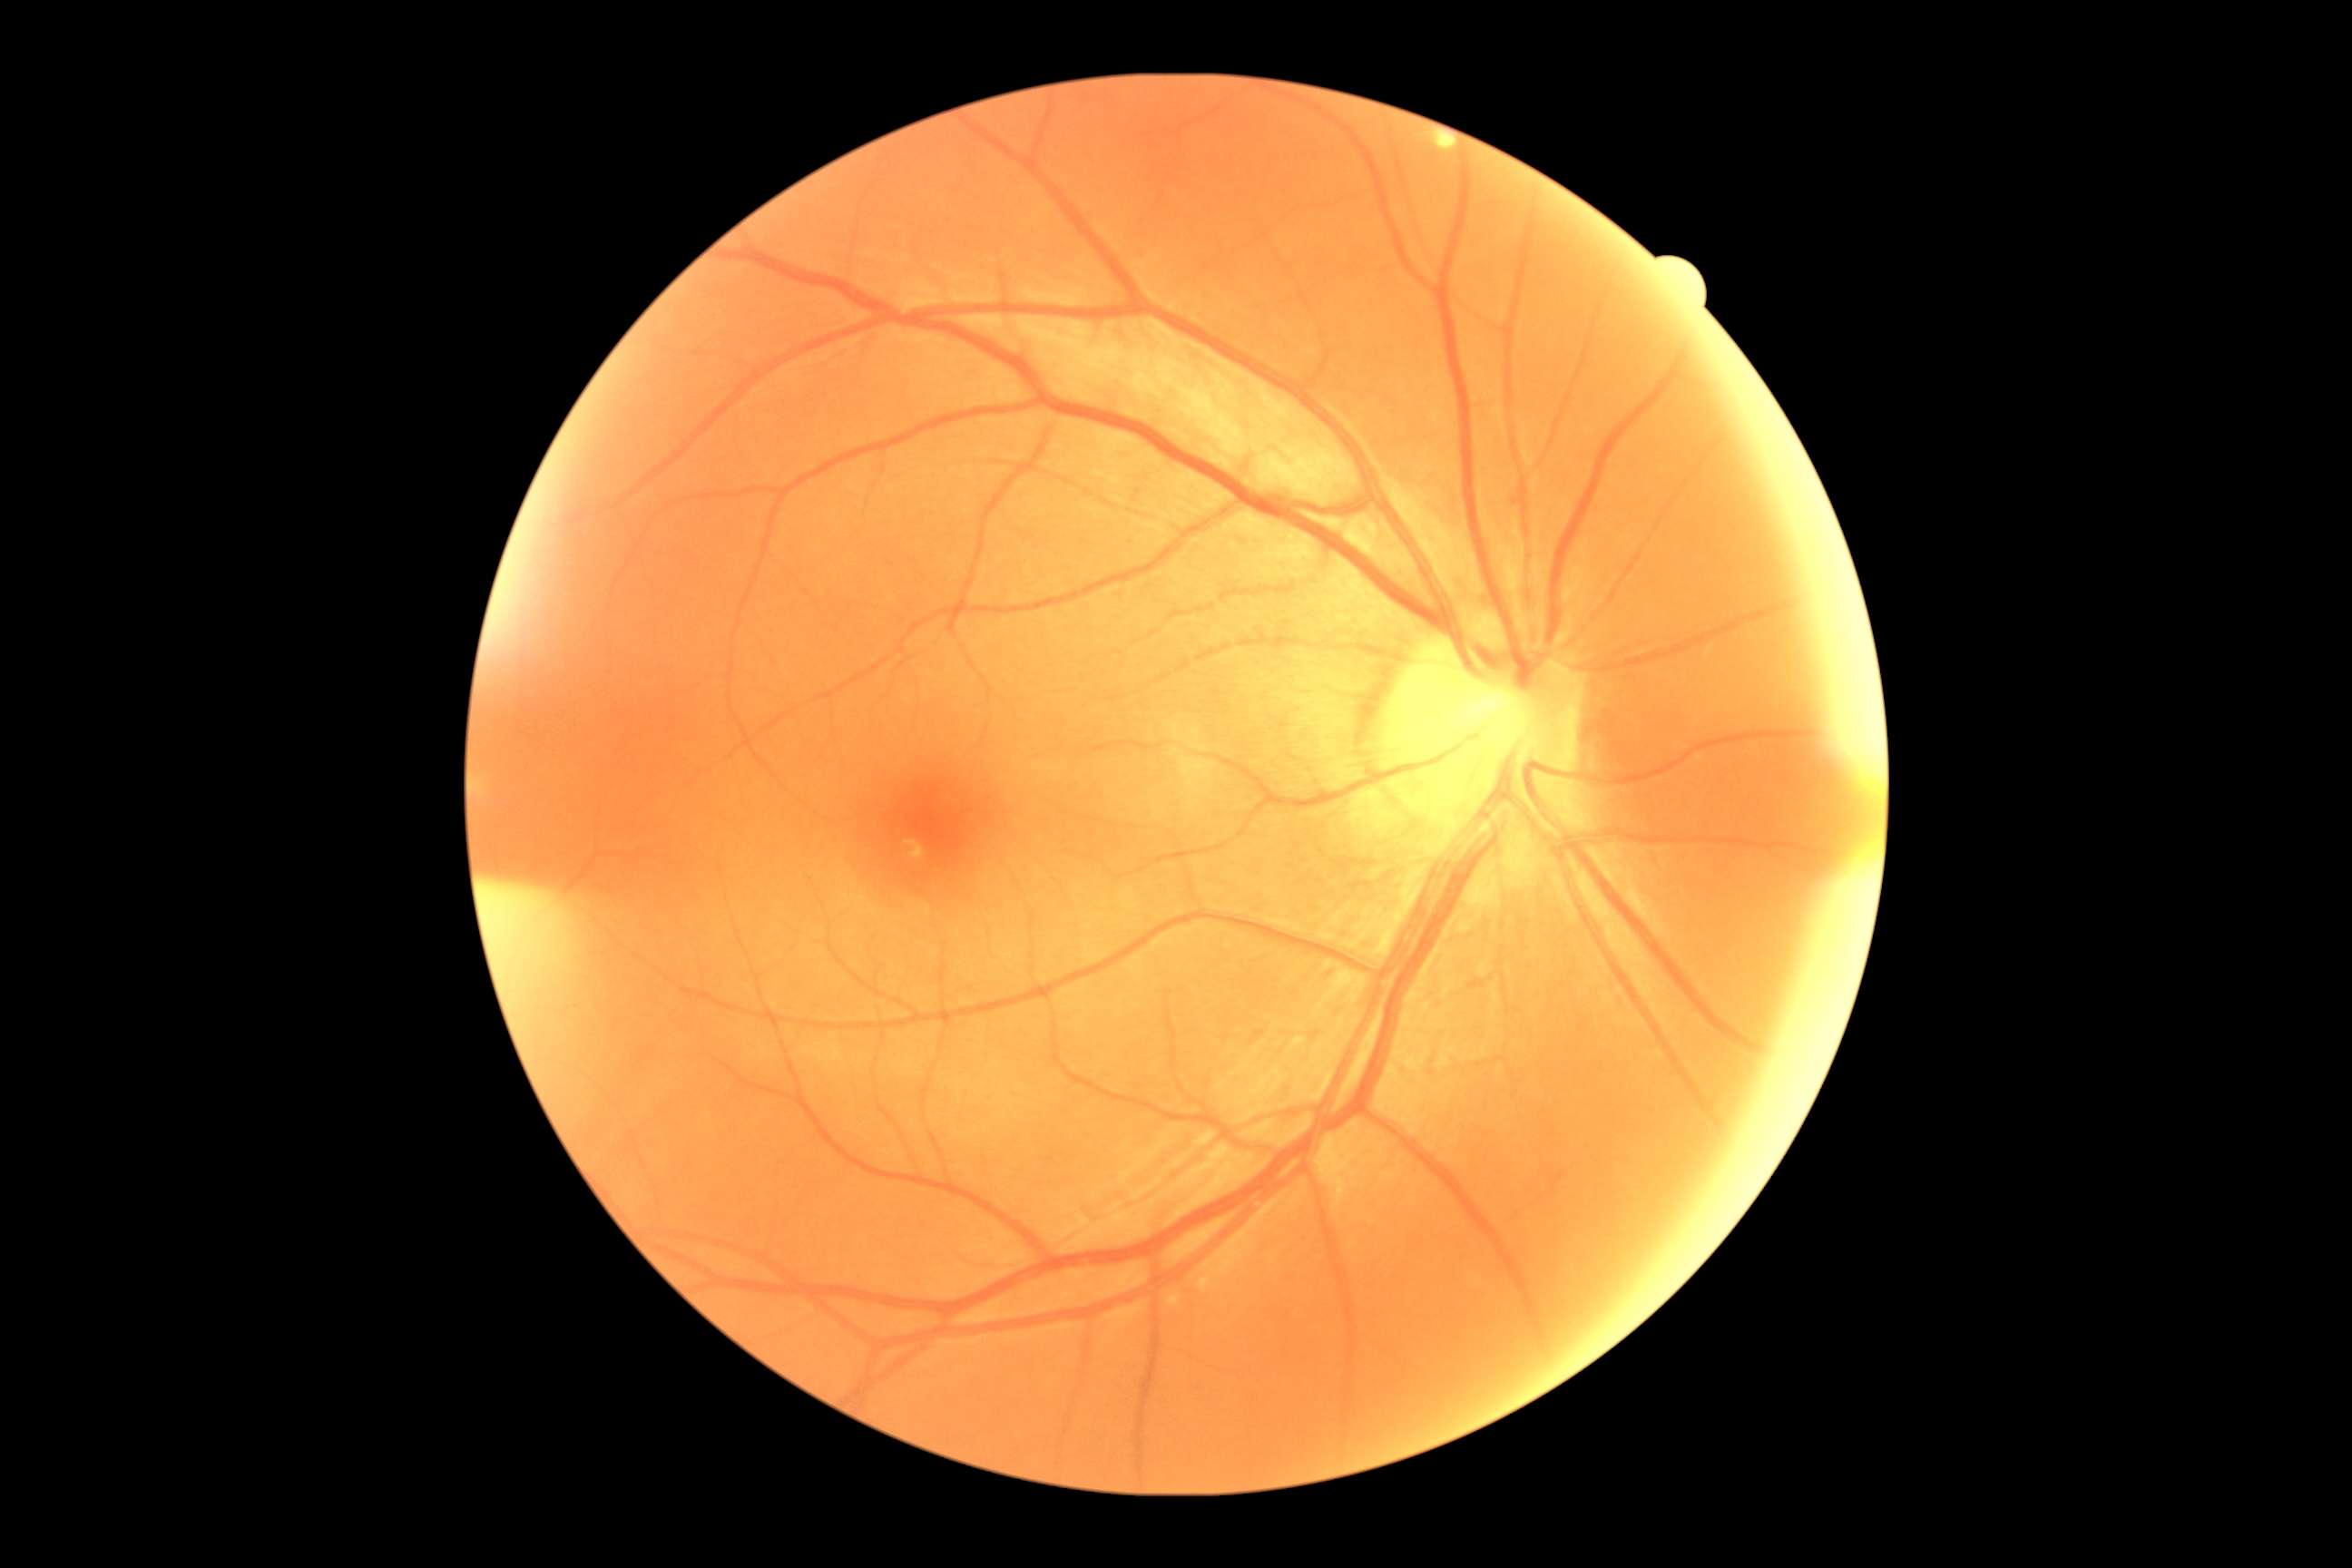 DR is 0/4.